Davis DR grading, camera: NIDEK AFC-230, 45 degree fundus photograph:
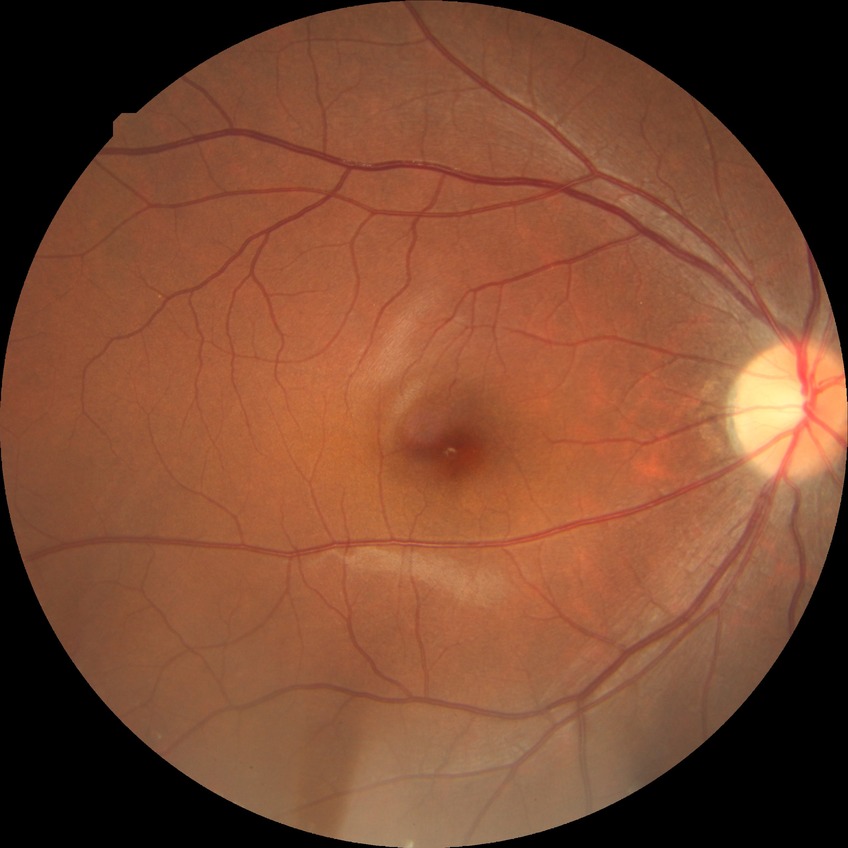

diabetic retinopathy (DR) = no diabetic retinopathy (NDR)